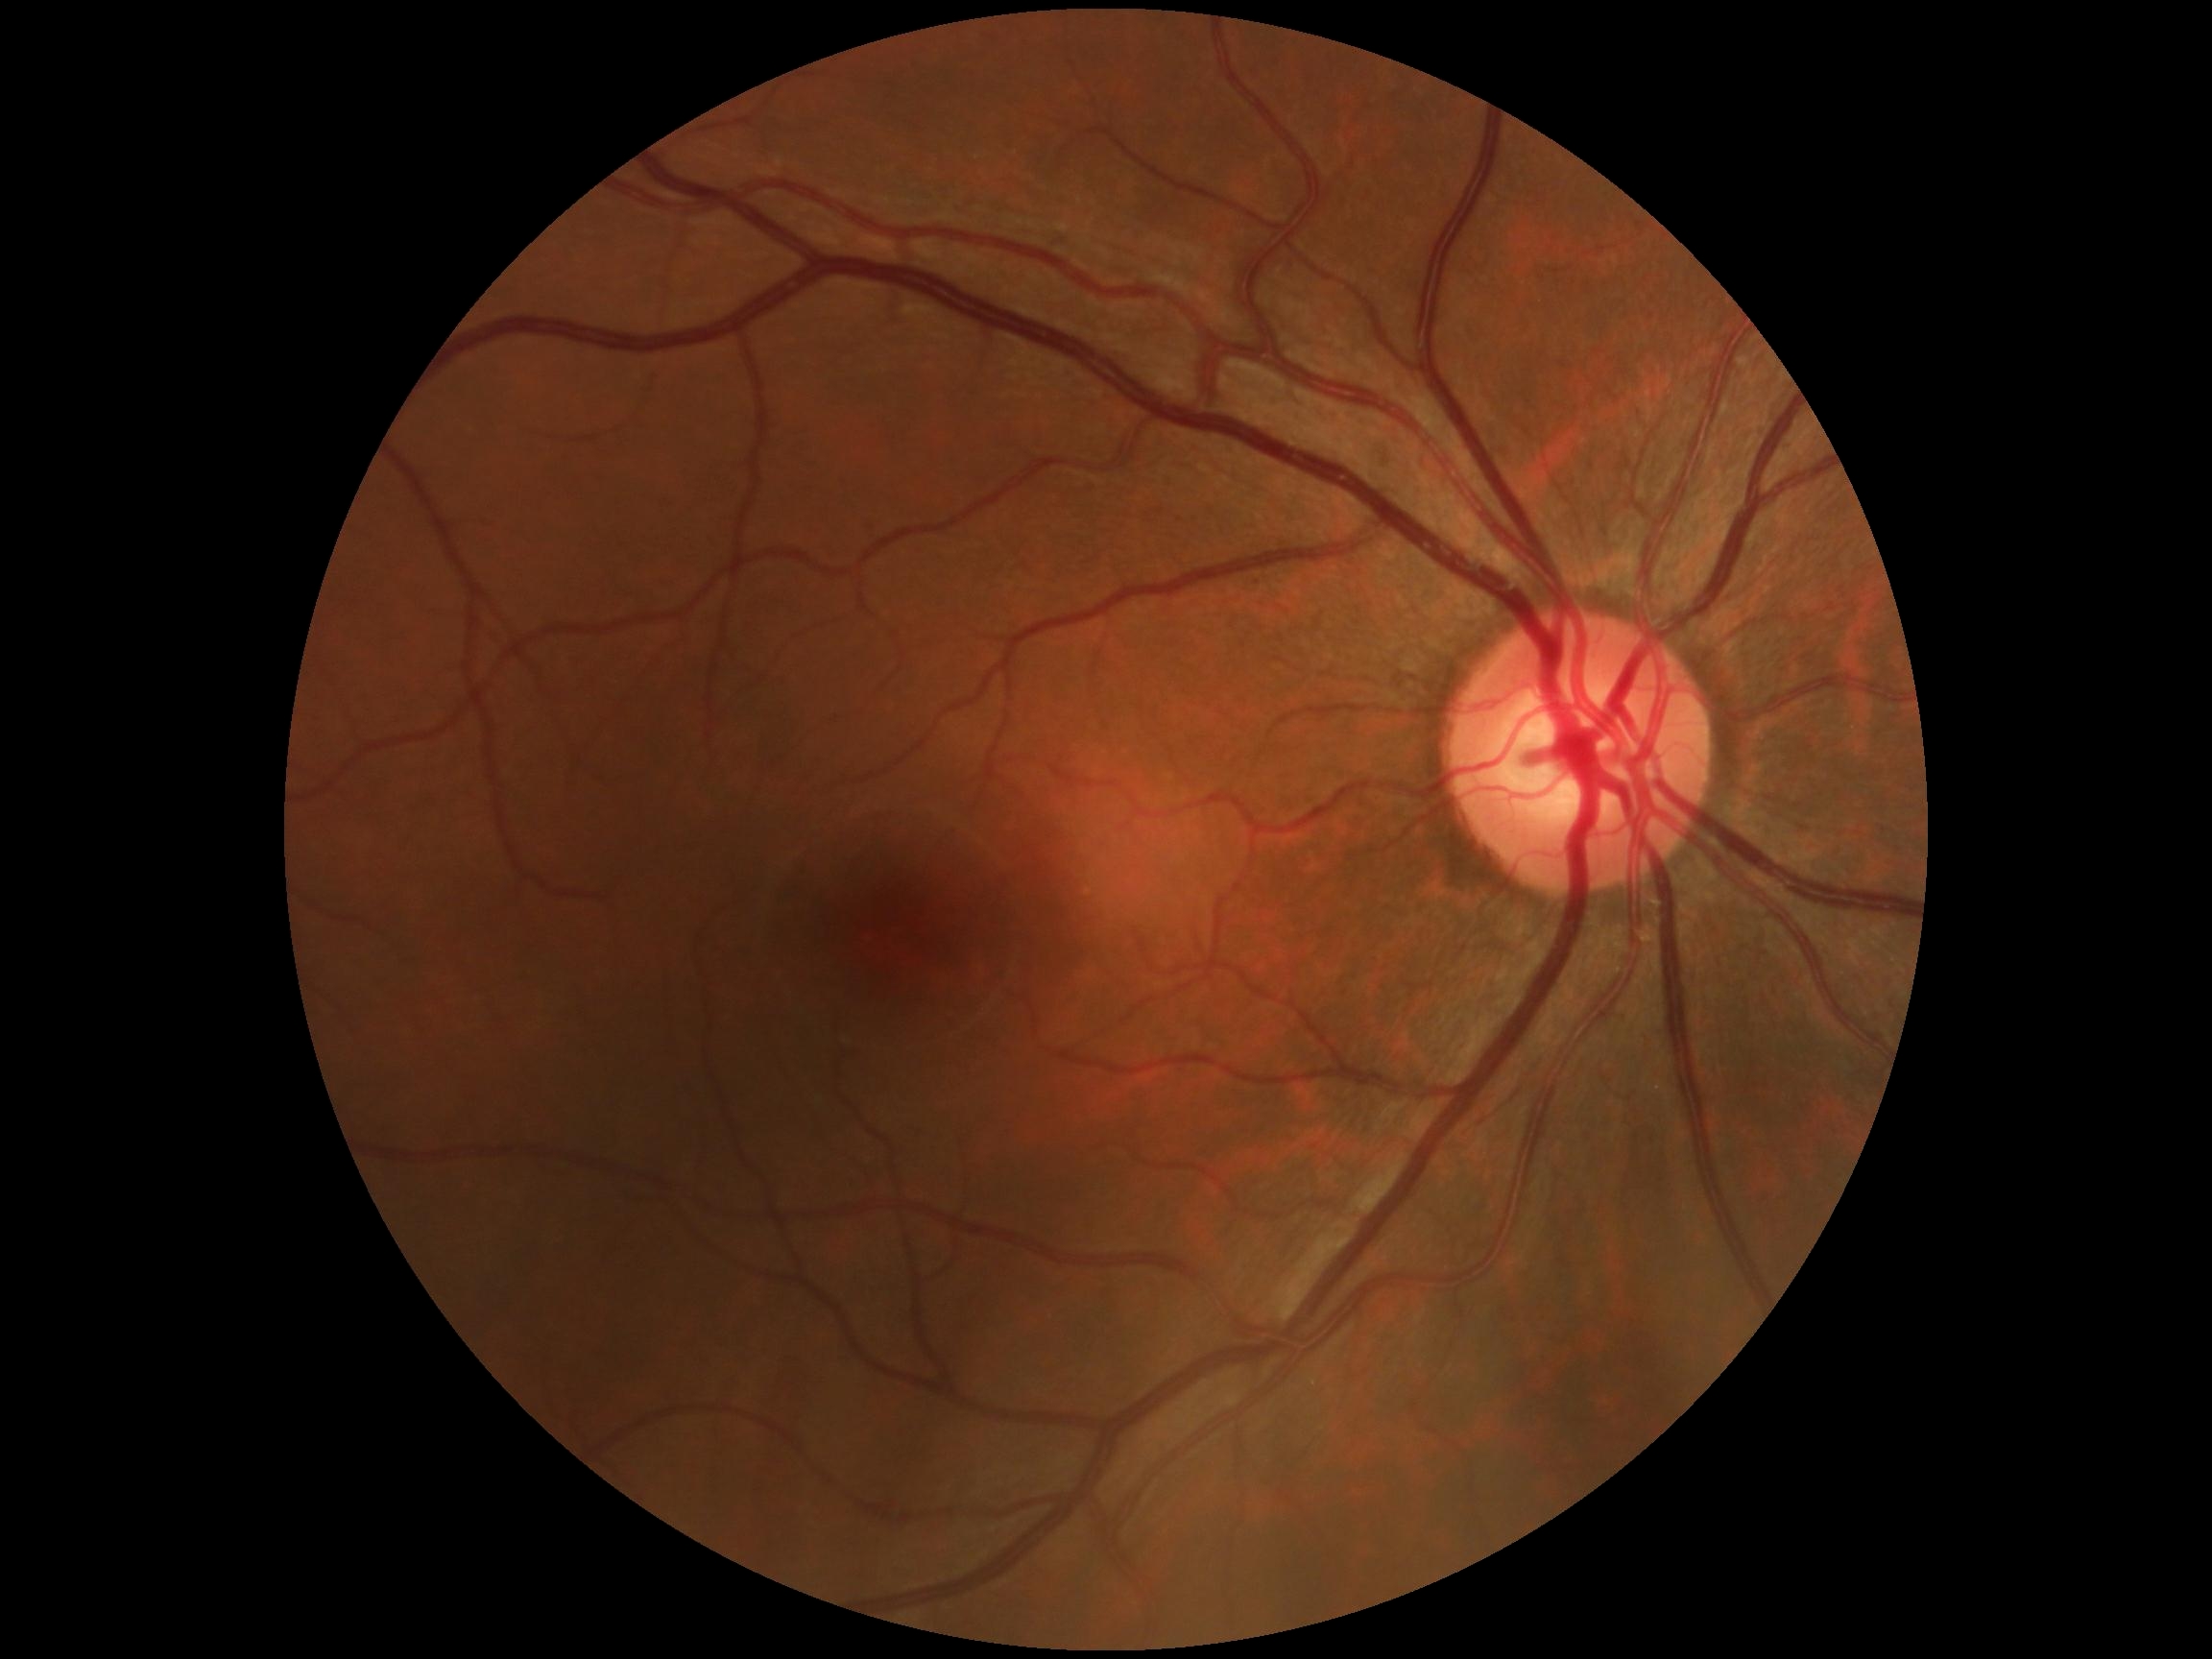 • DR grade: 0